2048x1536px · FOV: 45 degrees
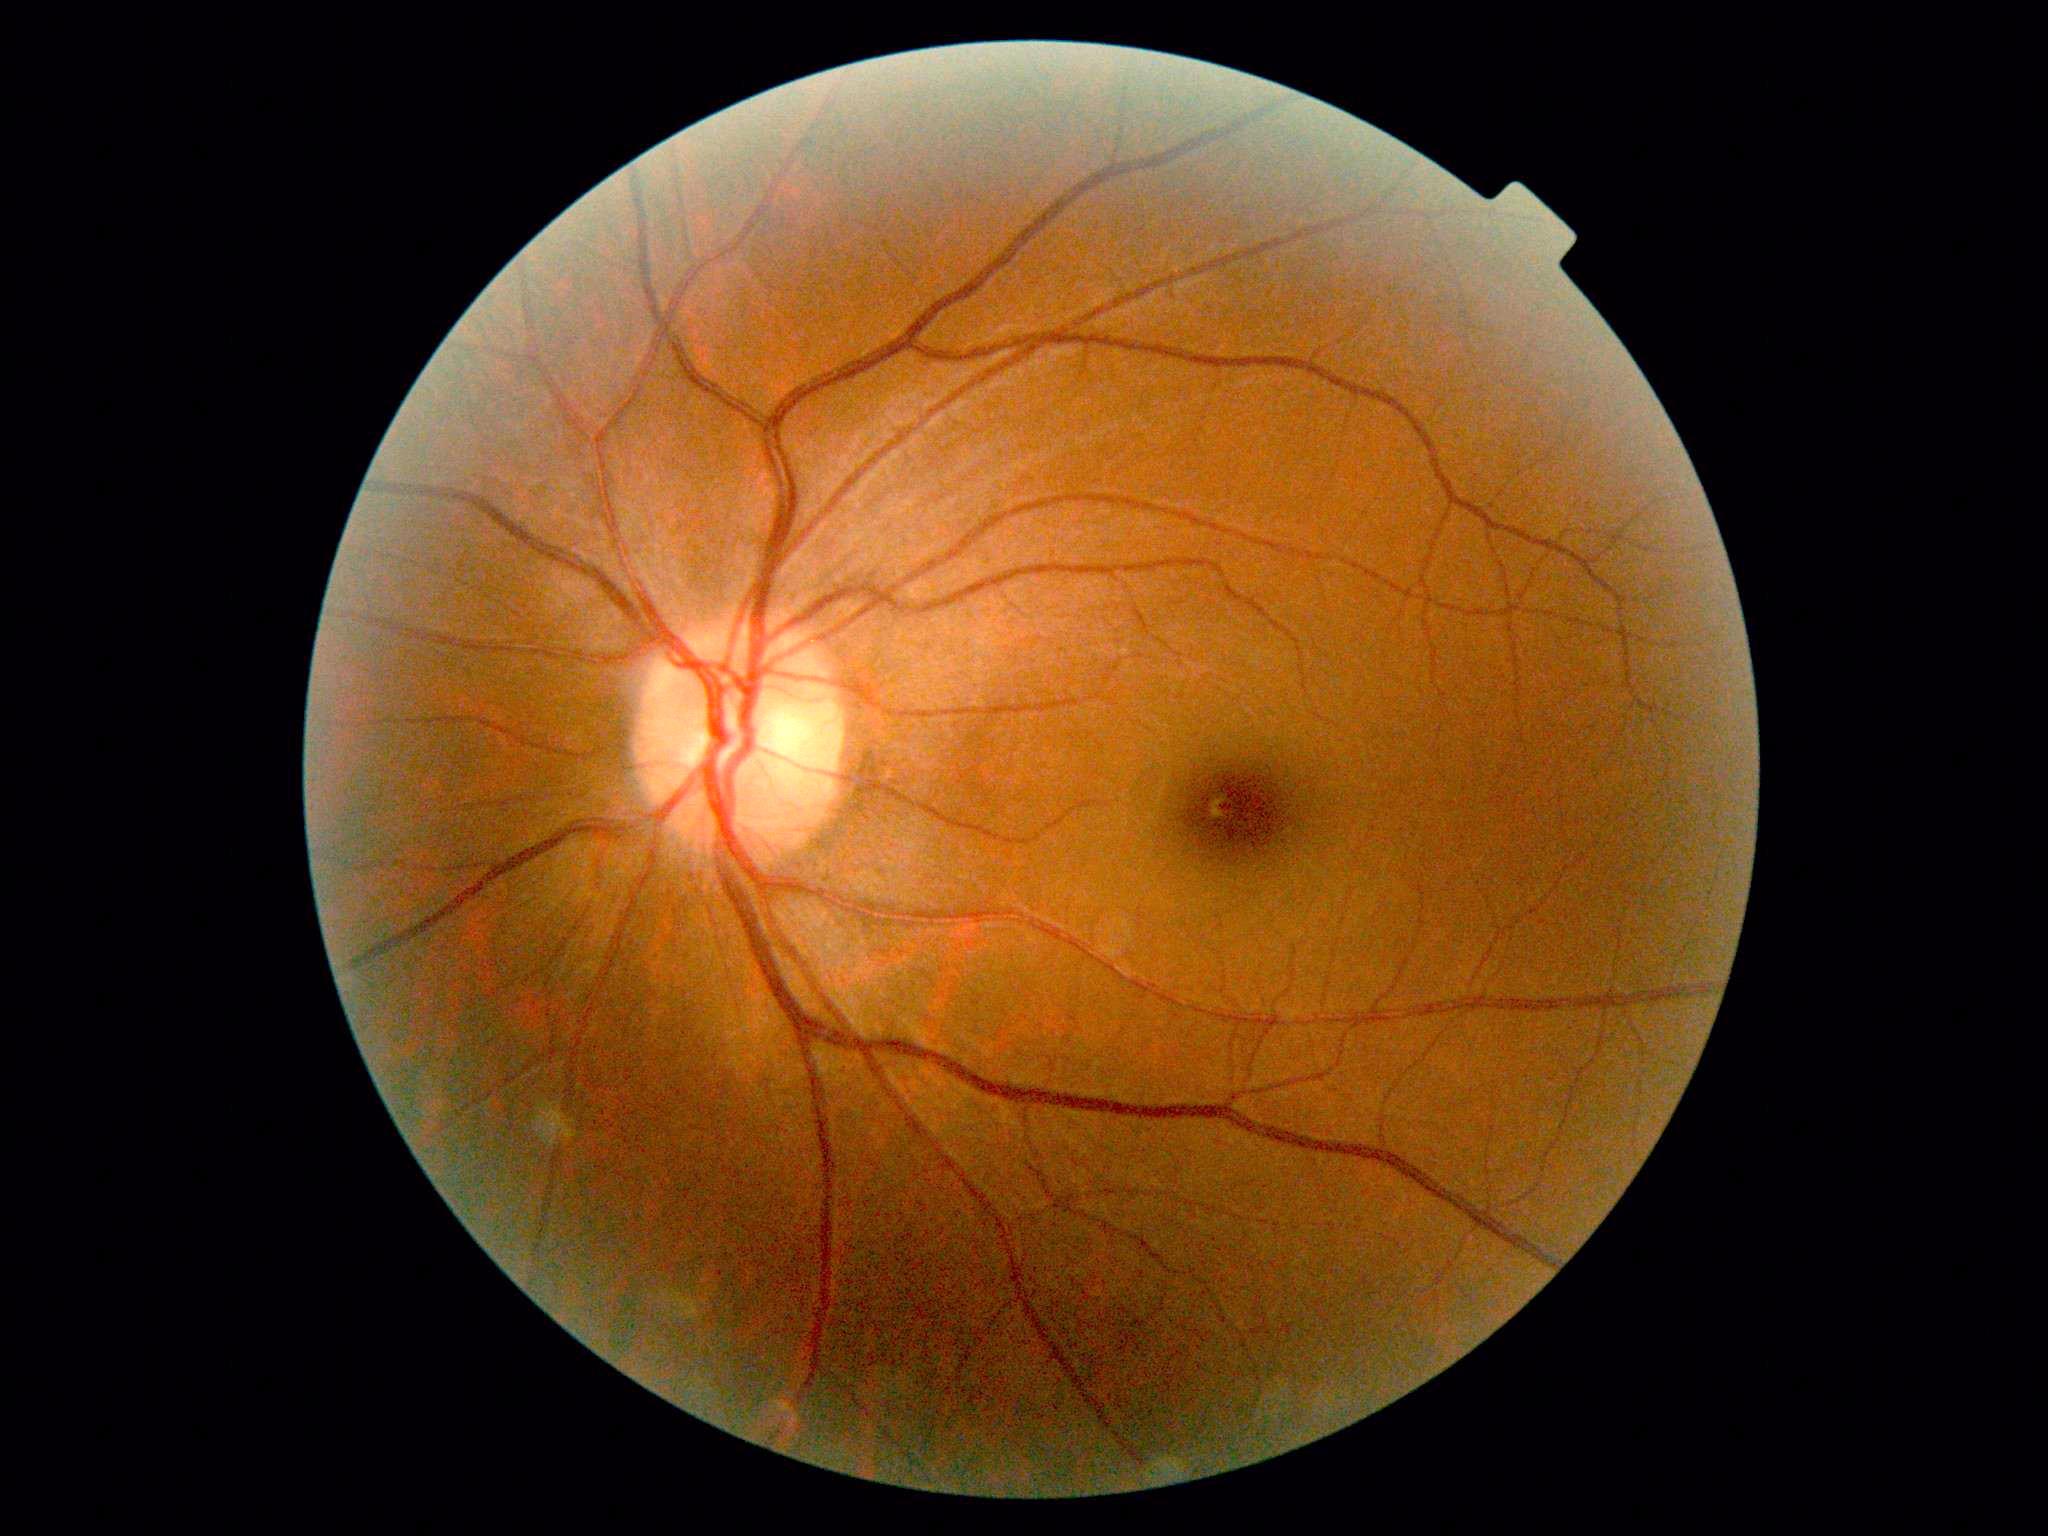
DR impression: no signs of DR; DR grade: 0/4.